45° FOV — 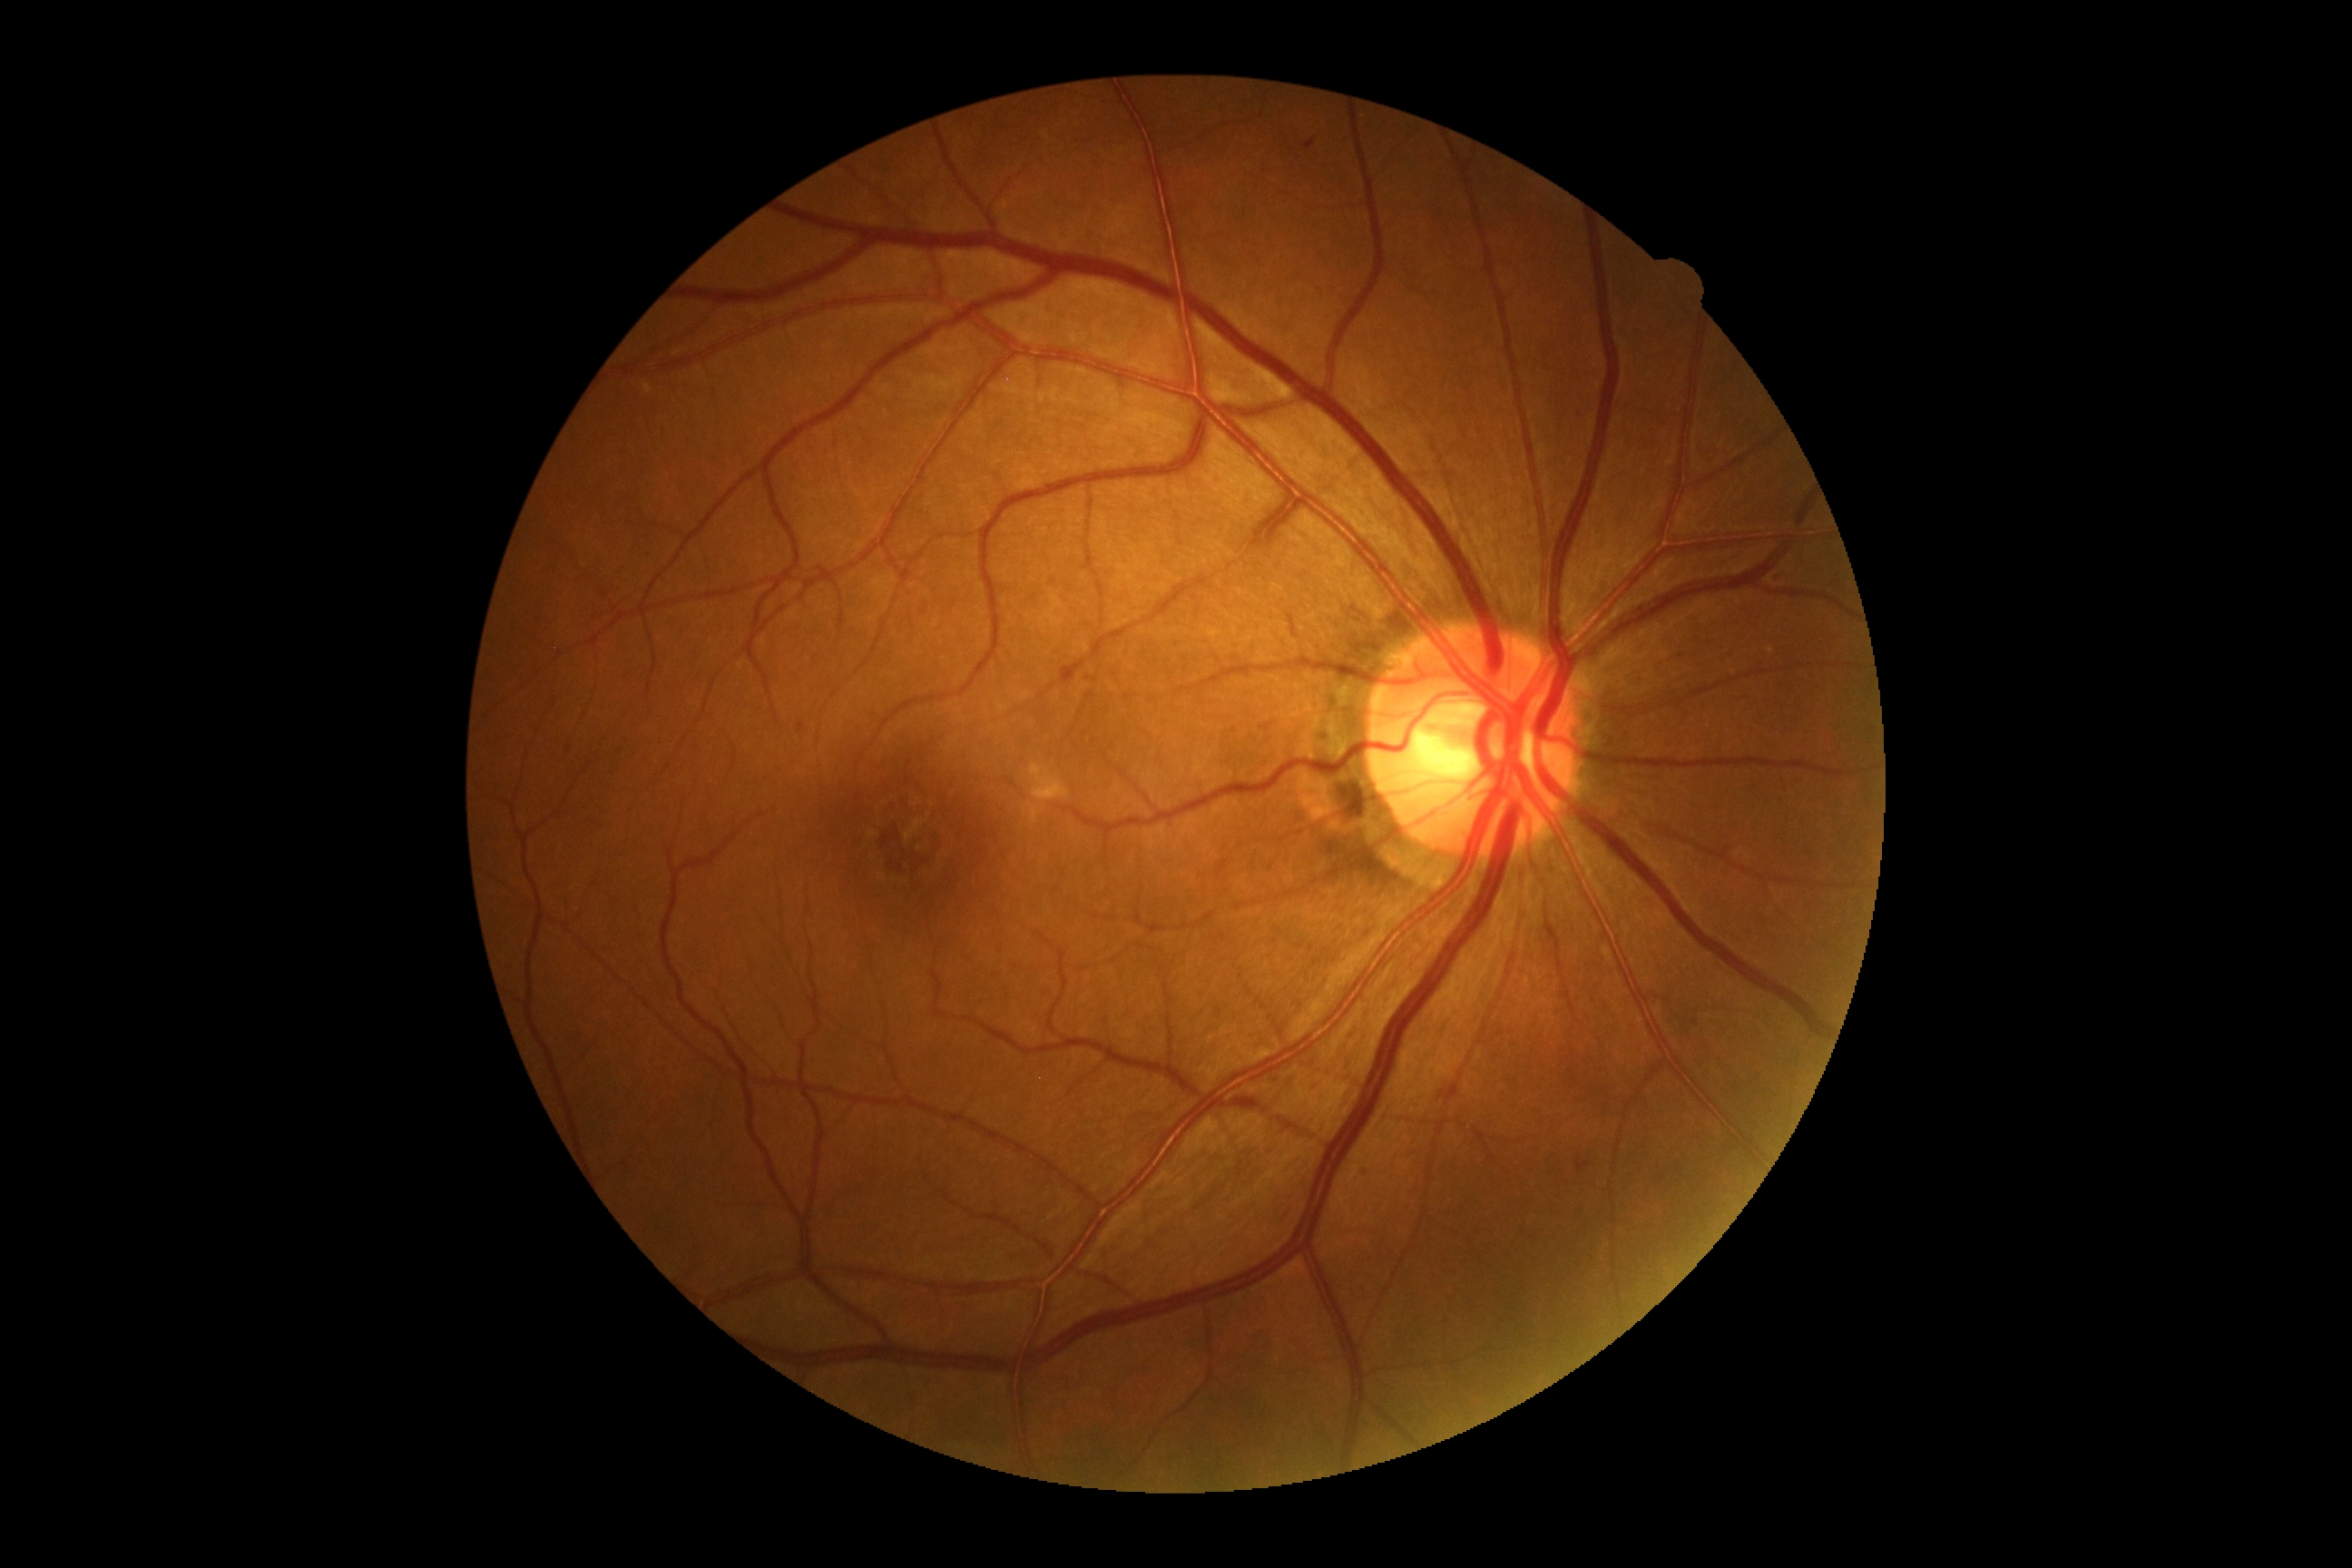
Diabetic retinopathy severity: moderate NPDR (grade 2) — more than just microaneurysms but less than severe NPDR. DR class: non-proliferative diabetic retinopathy.